Infant wide-field fundus photograph:
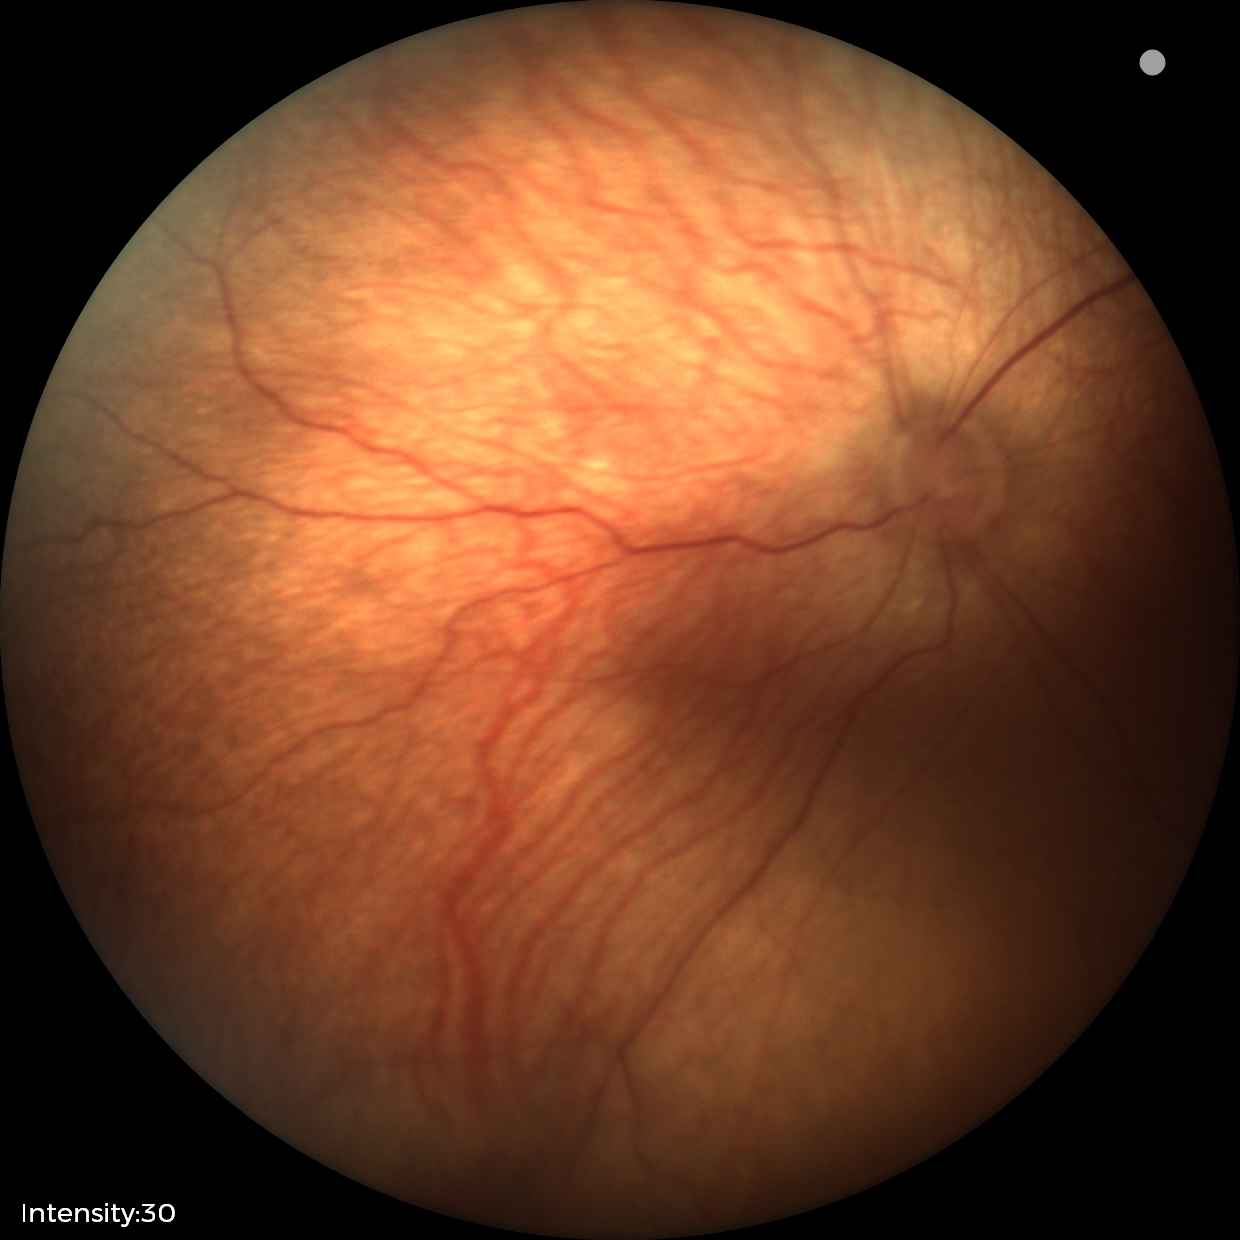
Screening diagnosis: physiological retinal finding.